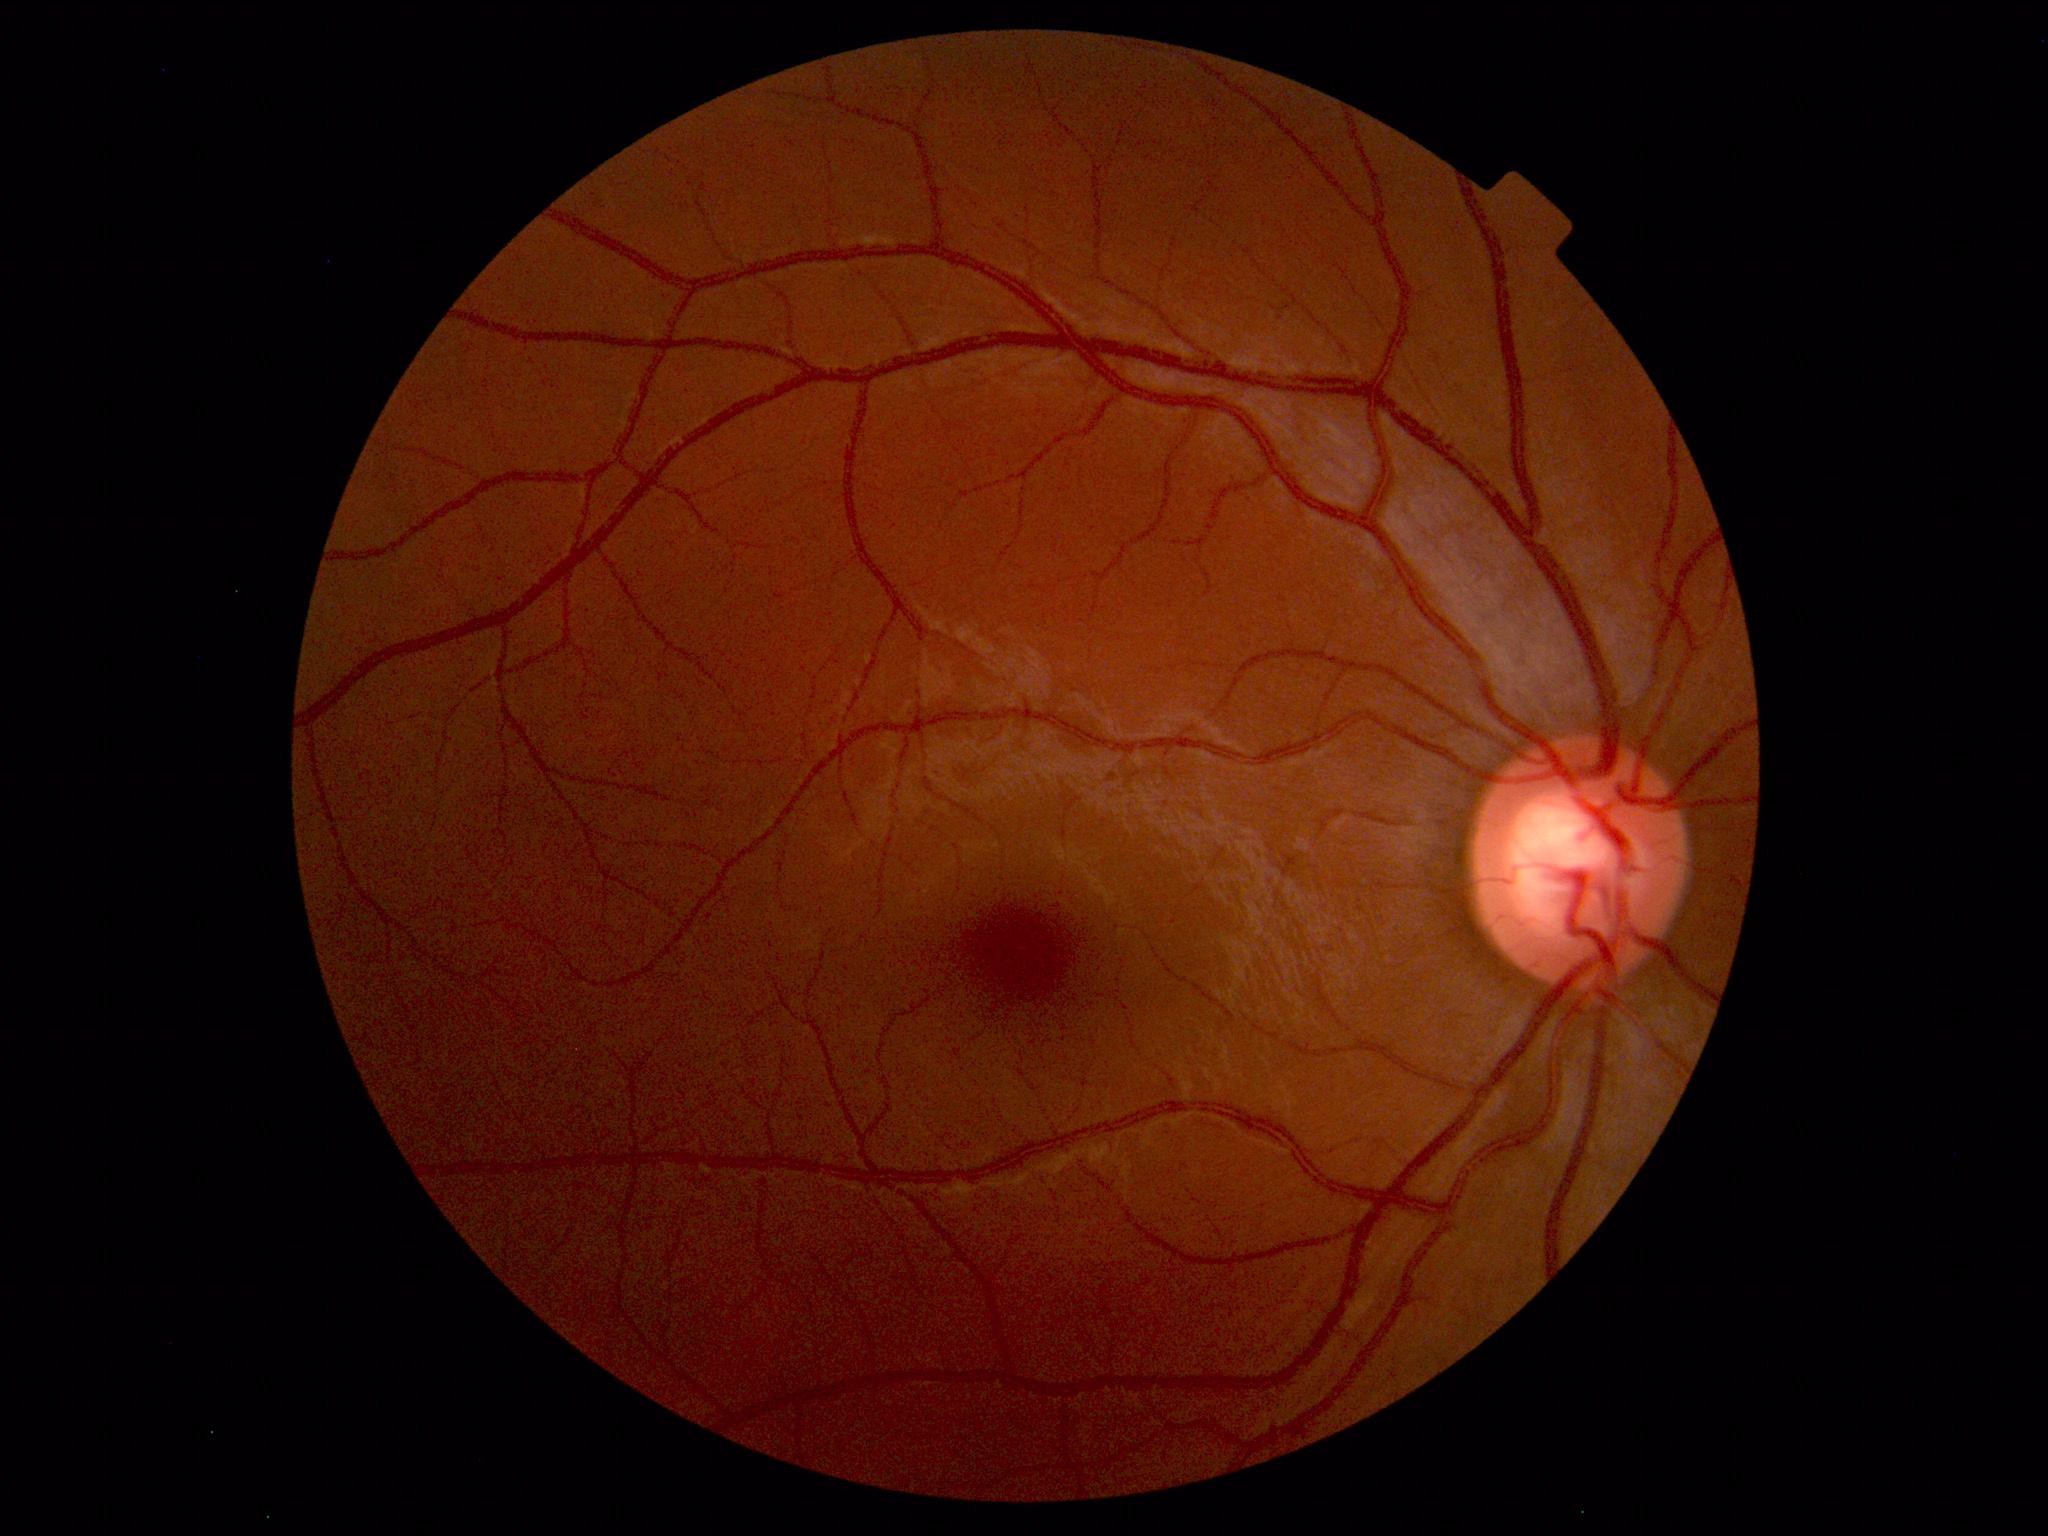
Unremarkable color fundus photograph.